2352x1568.
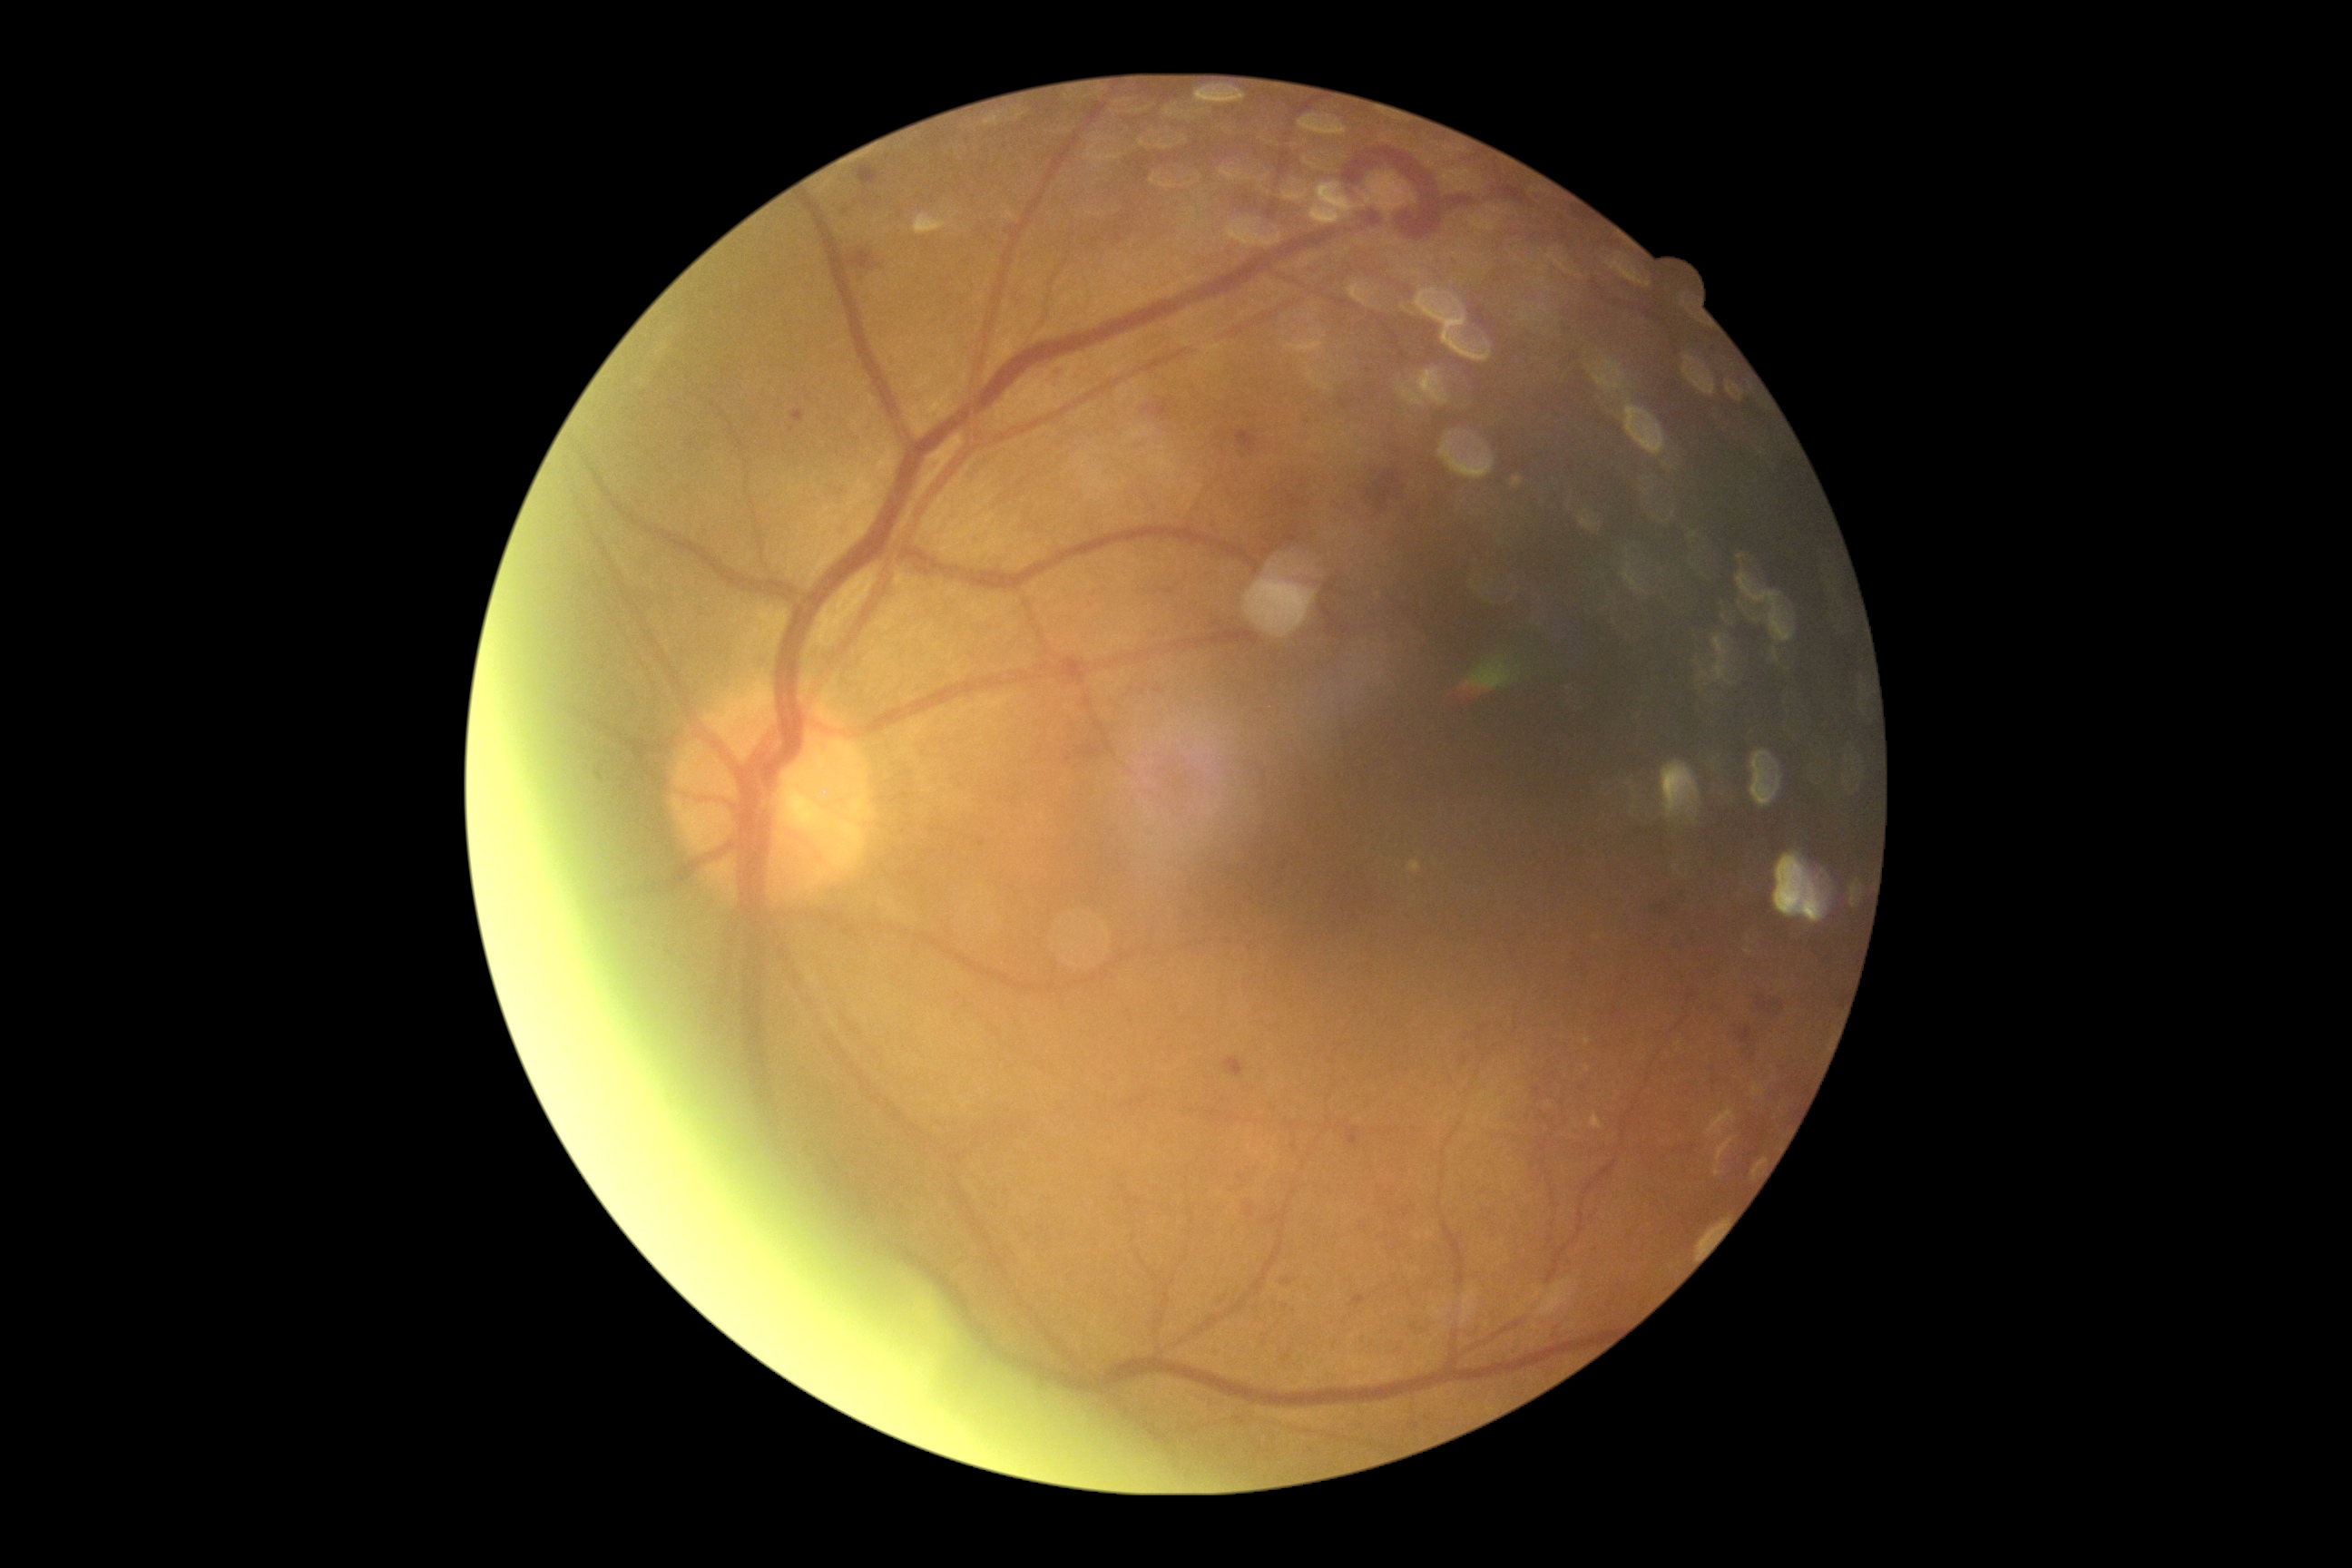

Diabetic retinopathy is 2/4.